NIDEK AFC-230. CFP — 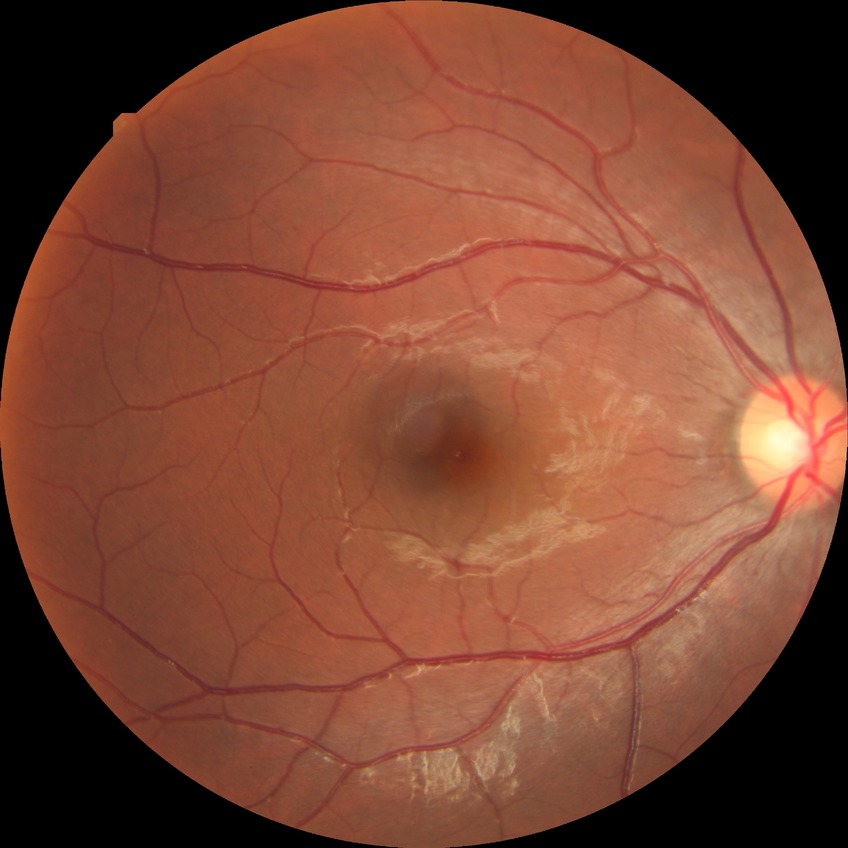

- diabetic retinopathy (DR) — NDR (no diabetic retinopathy)